Fundus image cropped to the optic disc
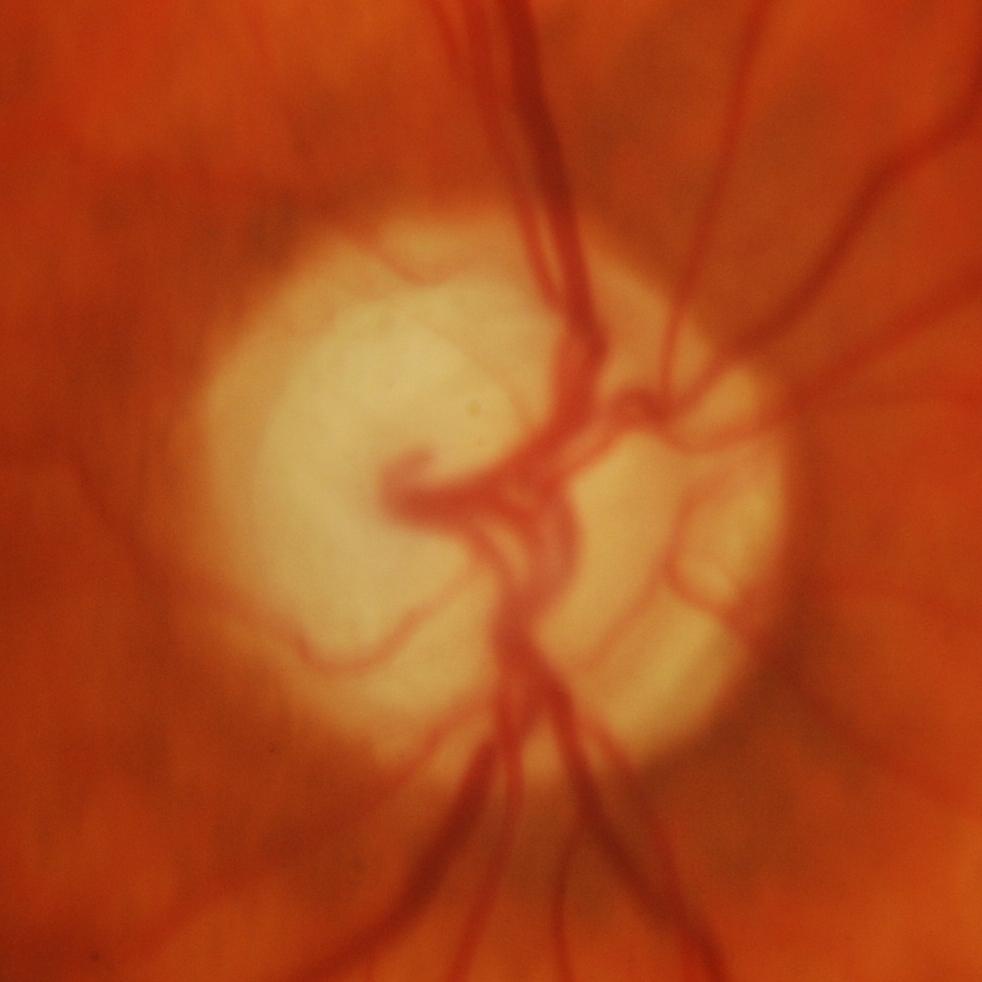
There is evidence of glaucomatous optic neuropathy.